No pharmacologic dilation, acquired with a NIDEK AFC-230: 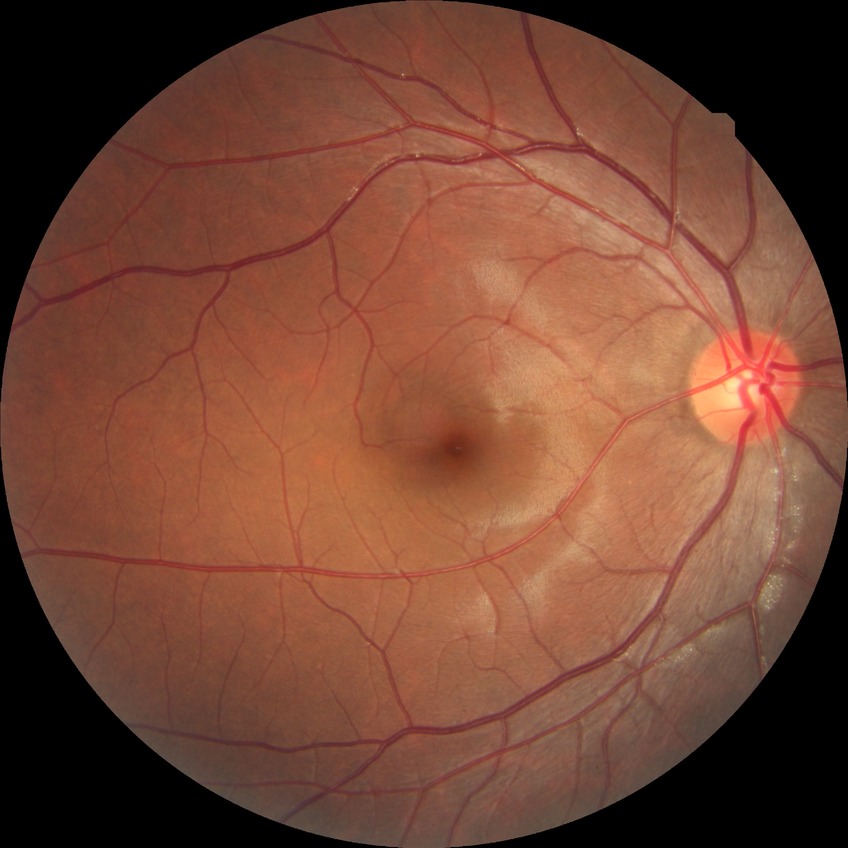 Diabetic retinopathy severity is no diabetic retinopathy.